1440x1080 · wide-field fundus photograph from neonatal ROP screening
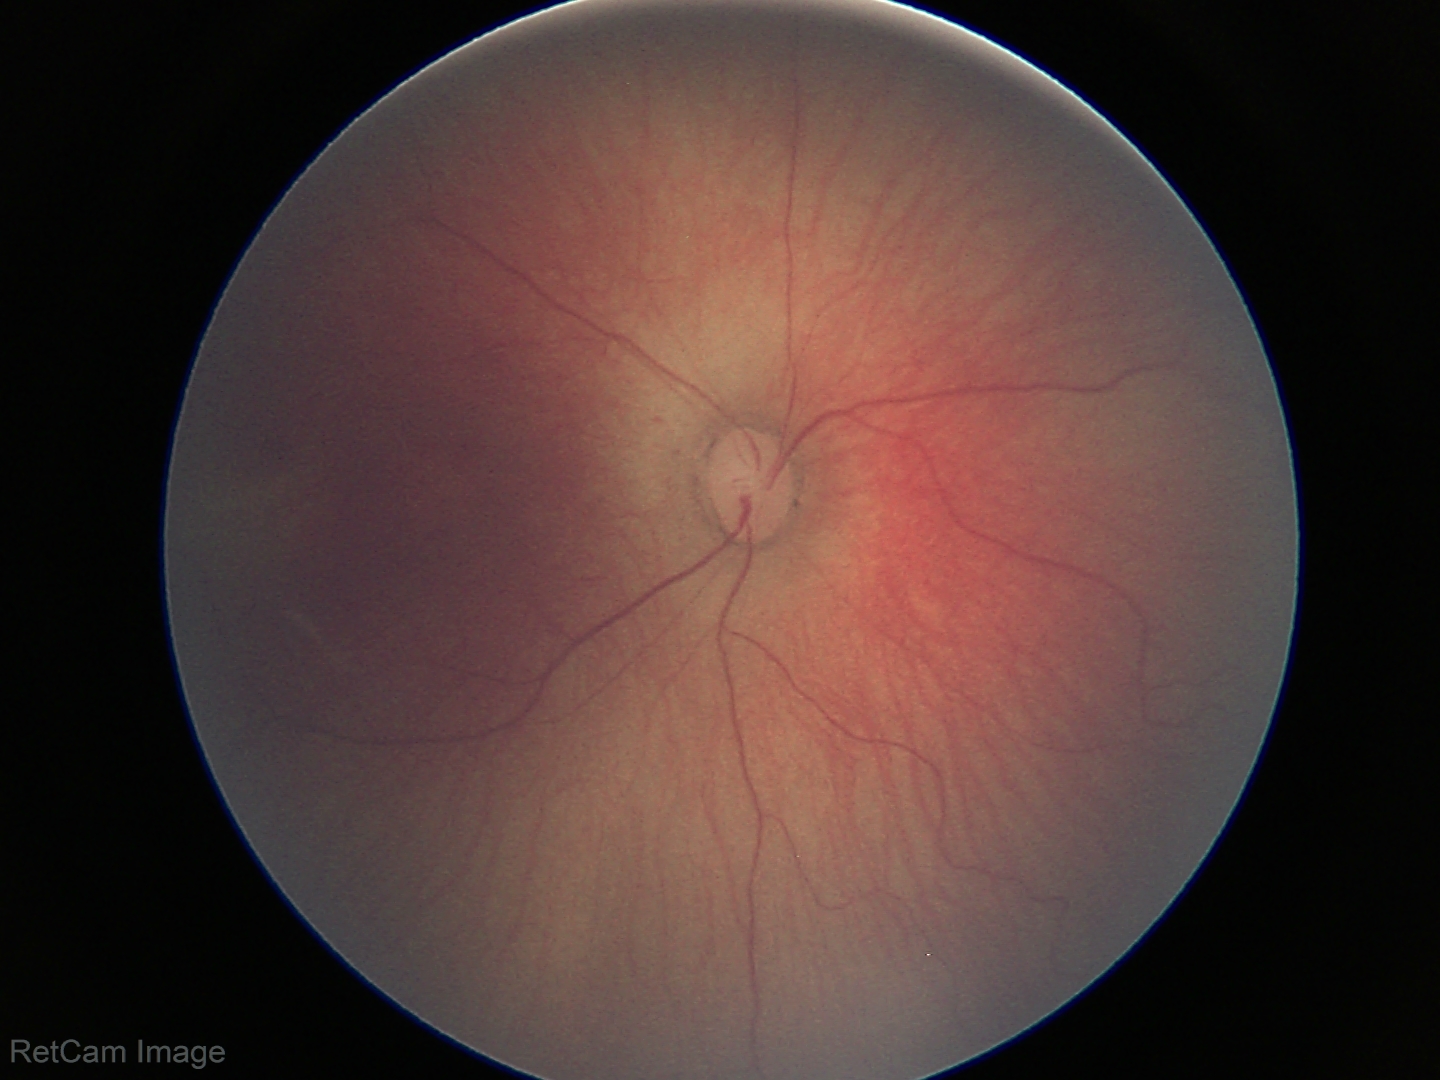

Q: Is plus disease present?
A: no plus disease
Q: What is the diagnosis from this examination?
A: ROP stage 1 — demarcation line between vascular and avascular retina